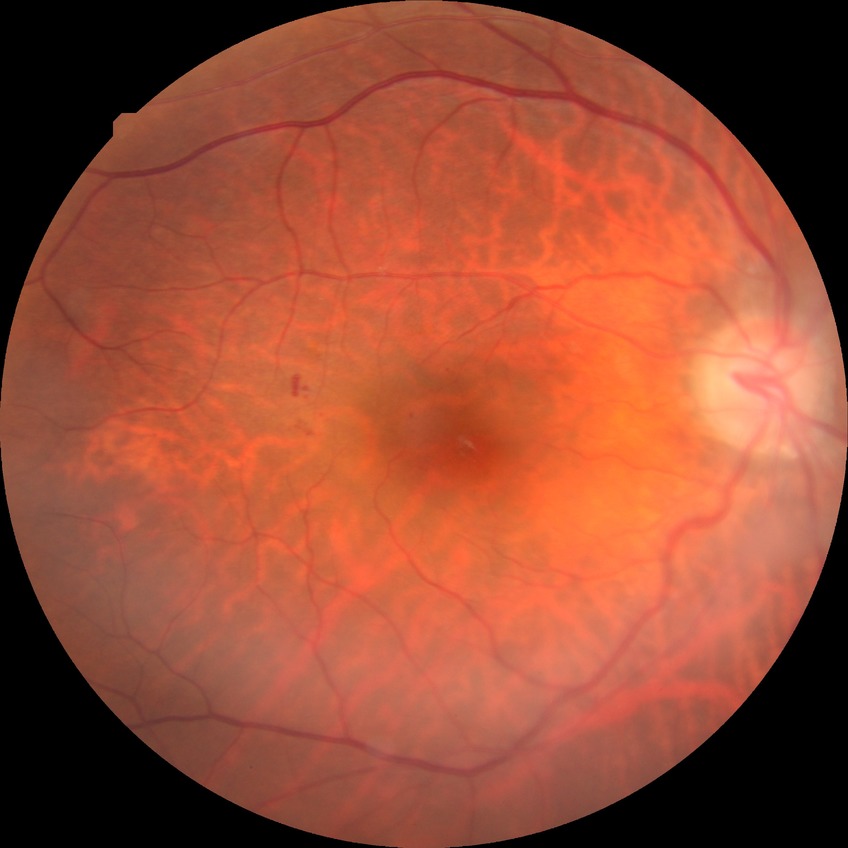 diabetic retinopathy stage: simple diabetic retinopathy